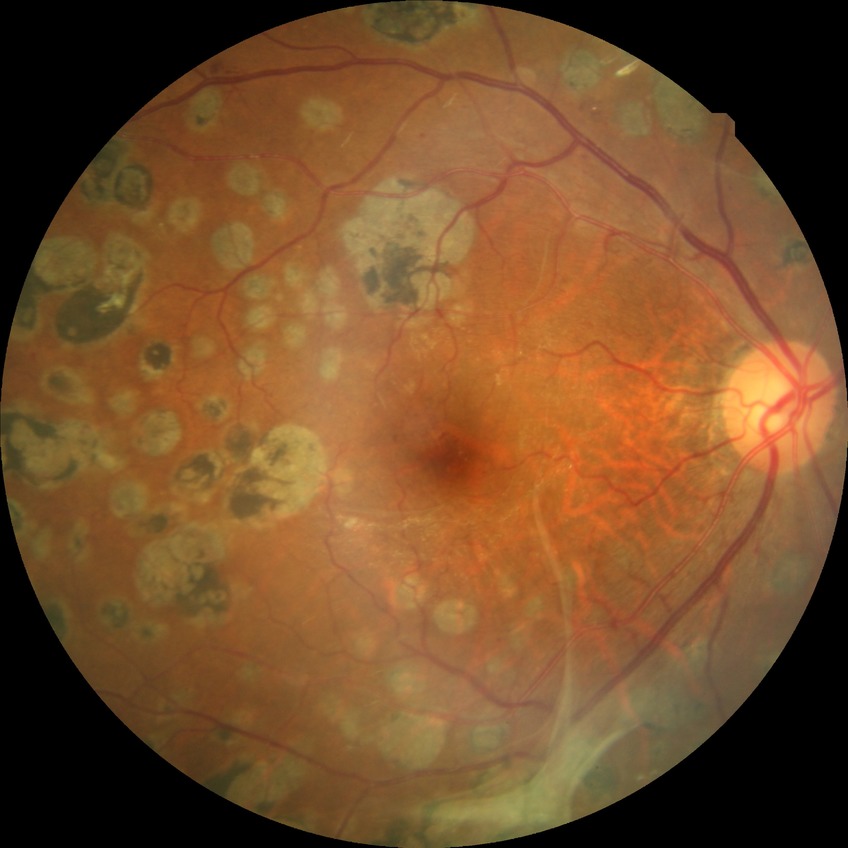
Diabetic retinopathy (DR) is proliferative diabetic retinopathy (PDR).